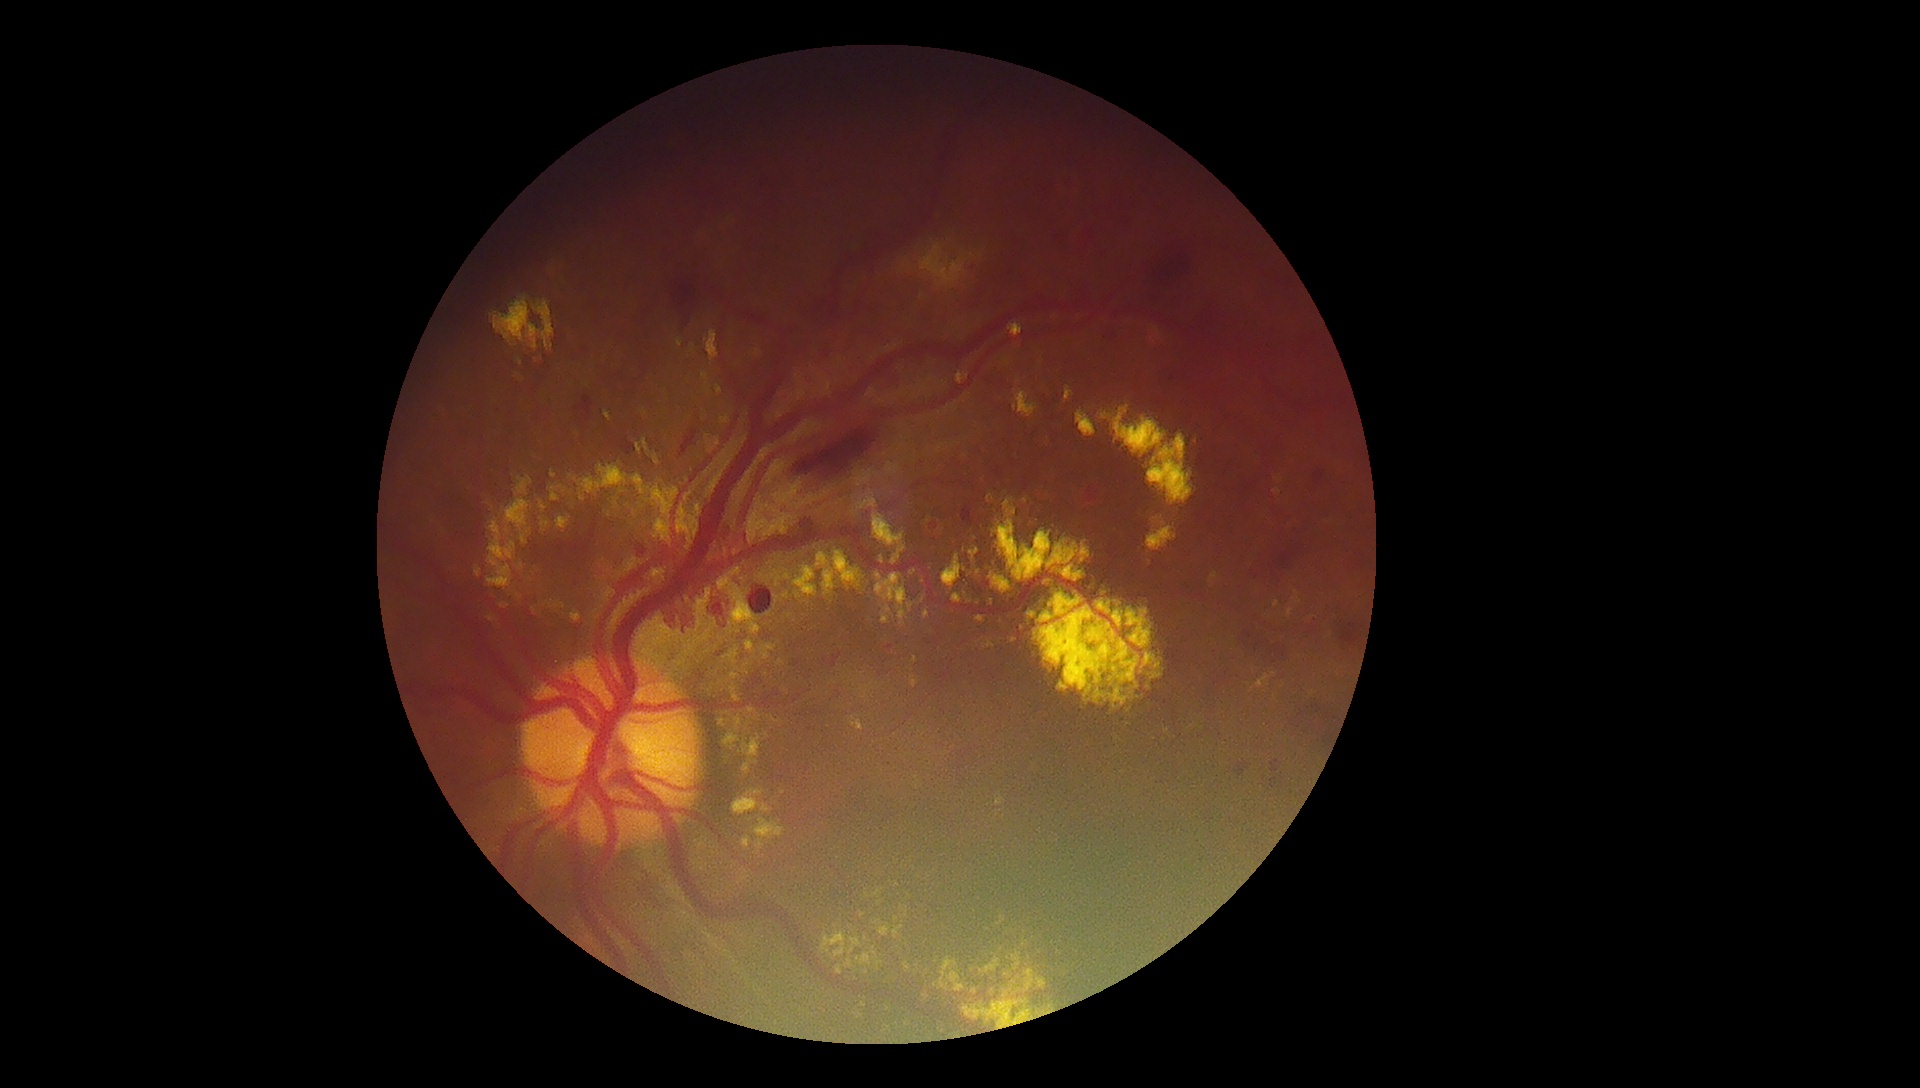 {"partial":true,"dr_grade":4,"lesions":{"ex":[[1273,488,1281,495],[731,668,741,681],[873,952,879,960],[551,344,554,352],[574,464,628,502],[738,734,763,776],[1256,674,1272,689],[604,410,612,422],[772,716,781,723],[636,439,661,466],[1012,637,1021,646],[771,570,782,587],[515,476,533,497]],"ex_small":[[798,595],[787,577],[923,601],[905,262],[888,925]]}}